2212x1659; CFP.
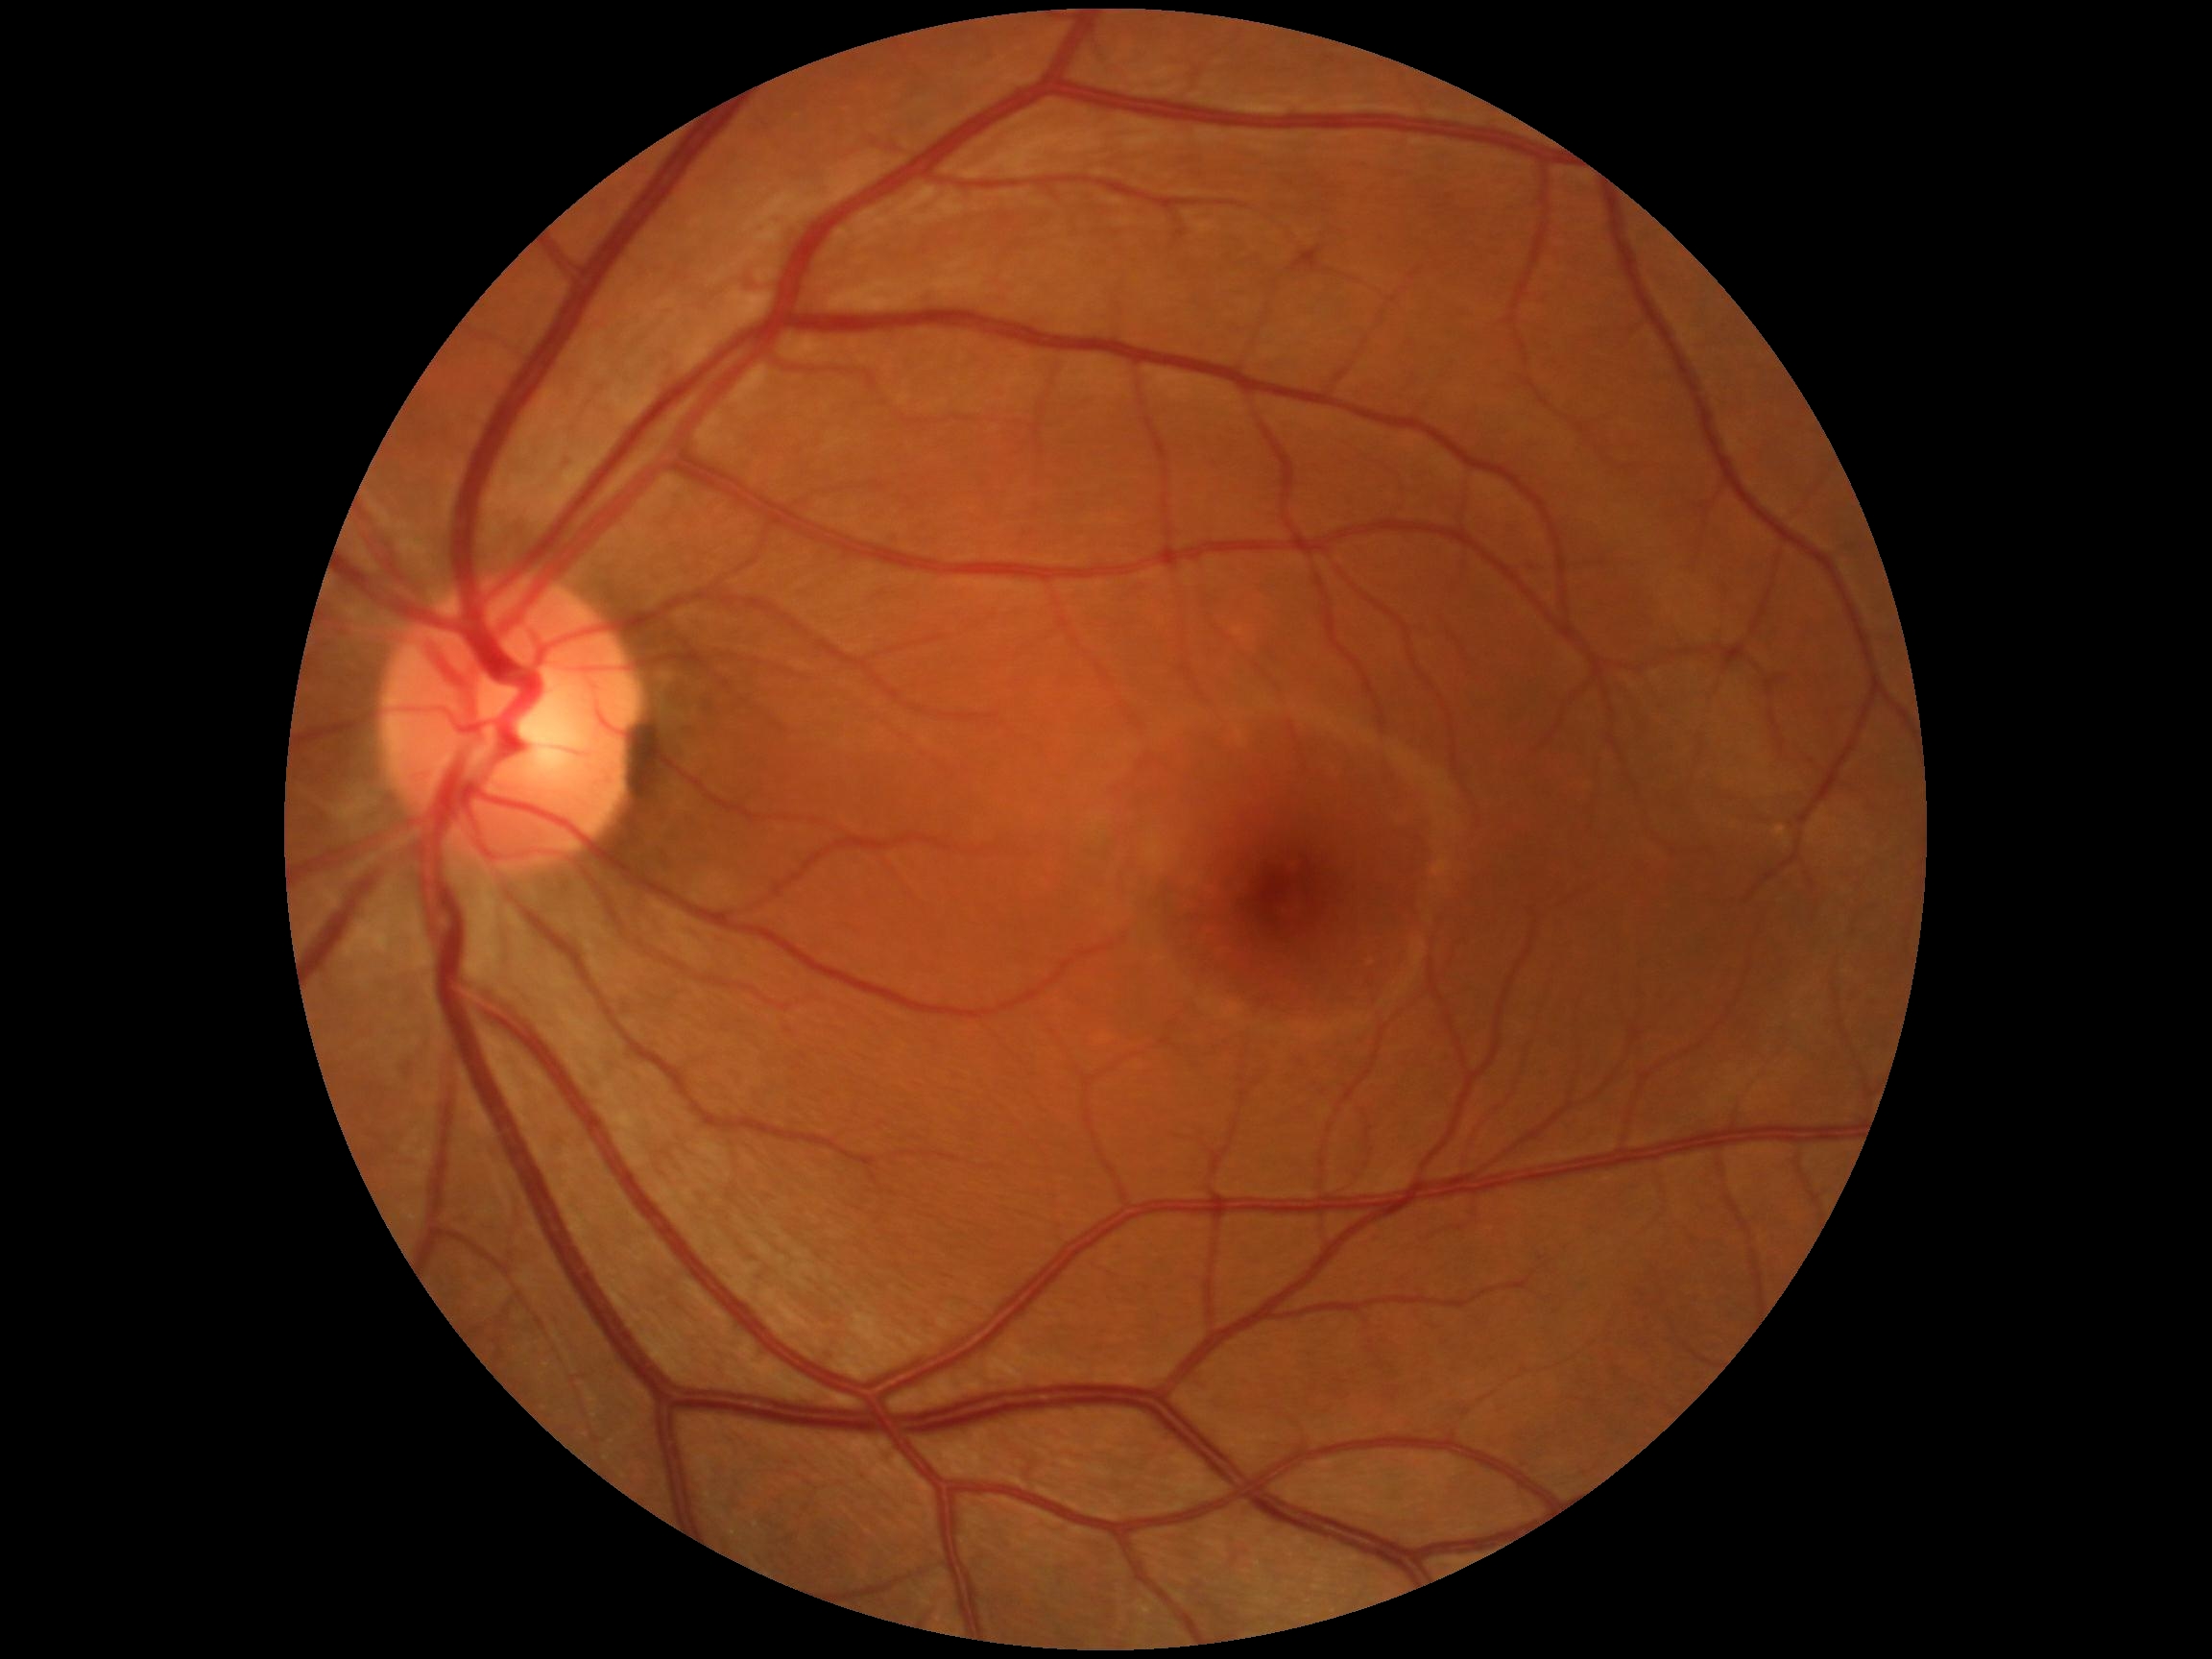

DR severity is no apparent retinopathy (grade 0).